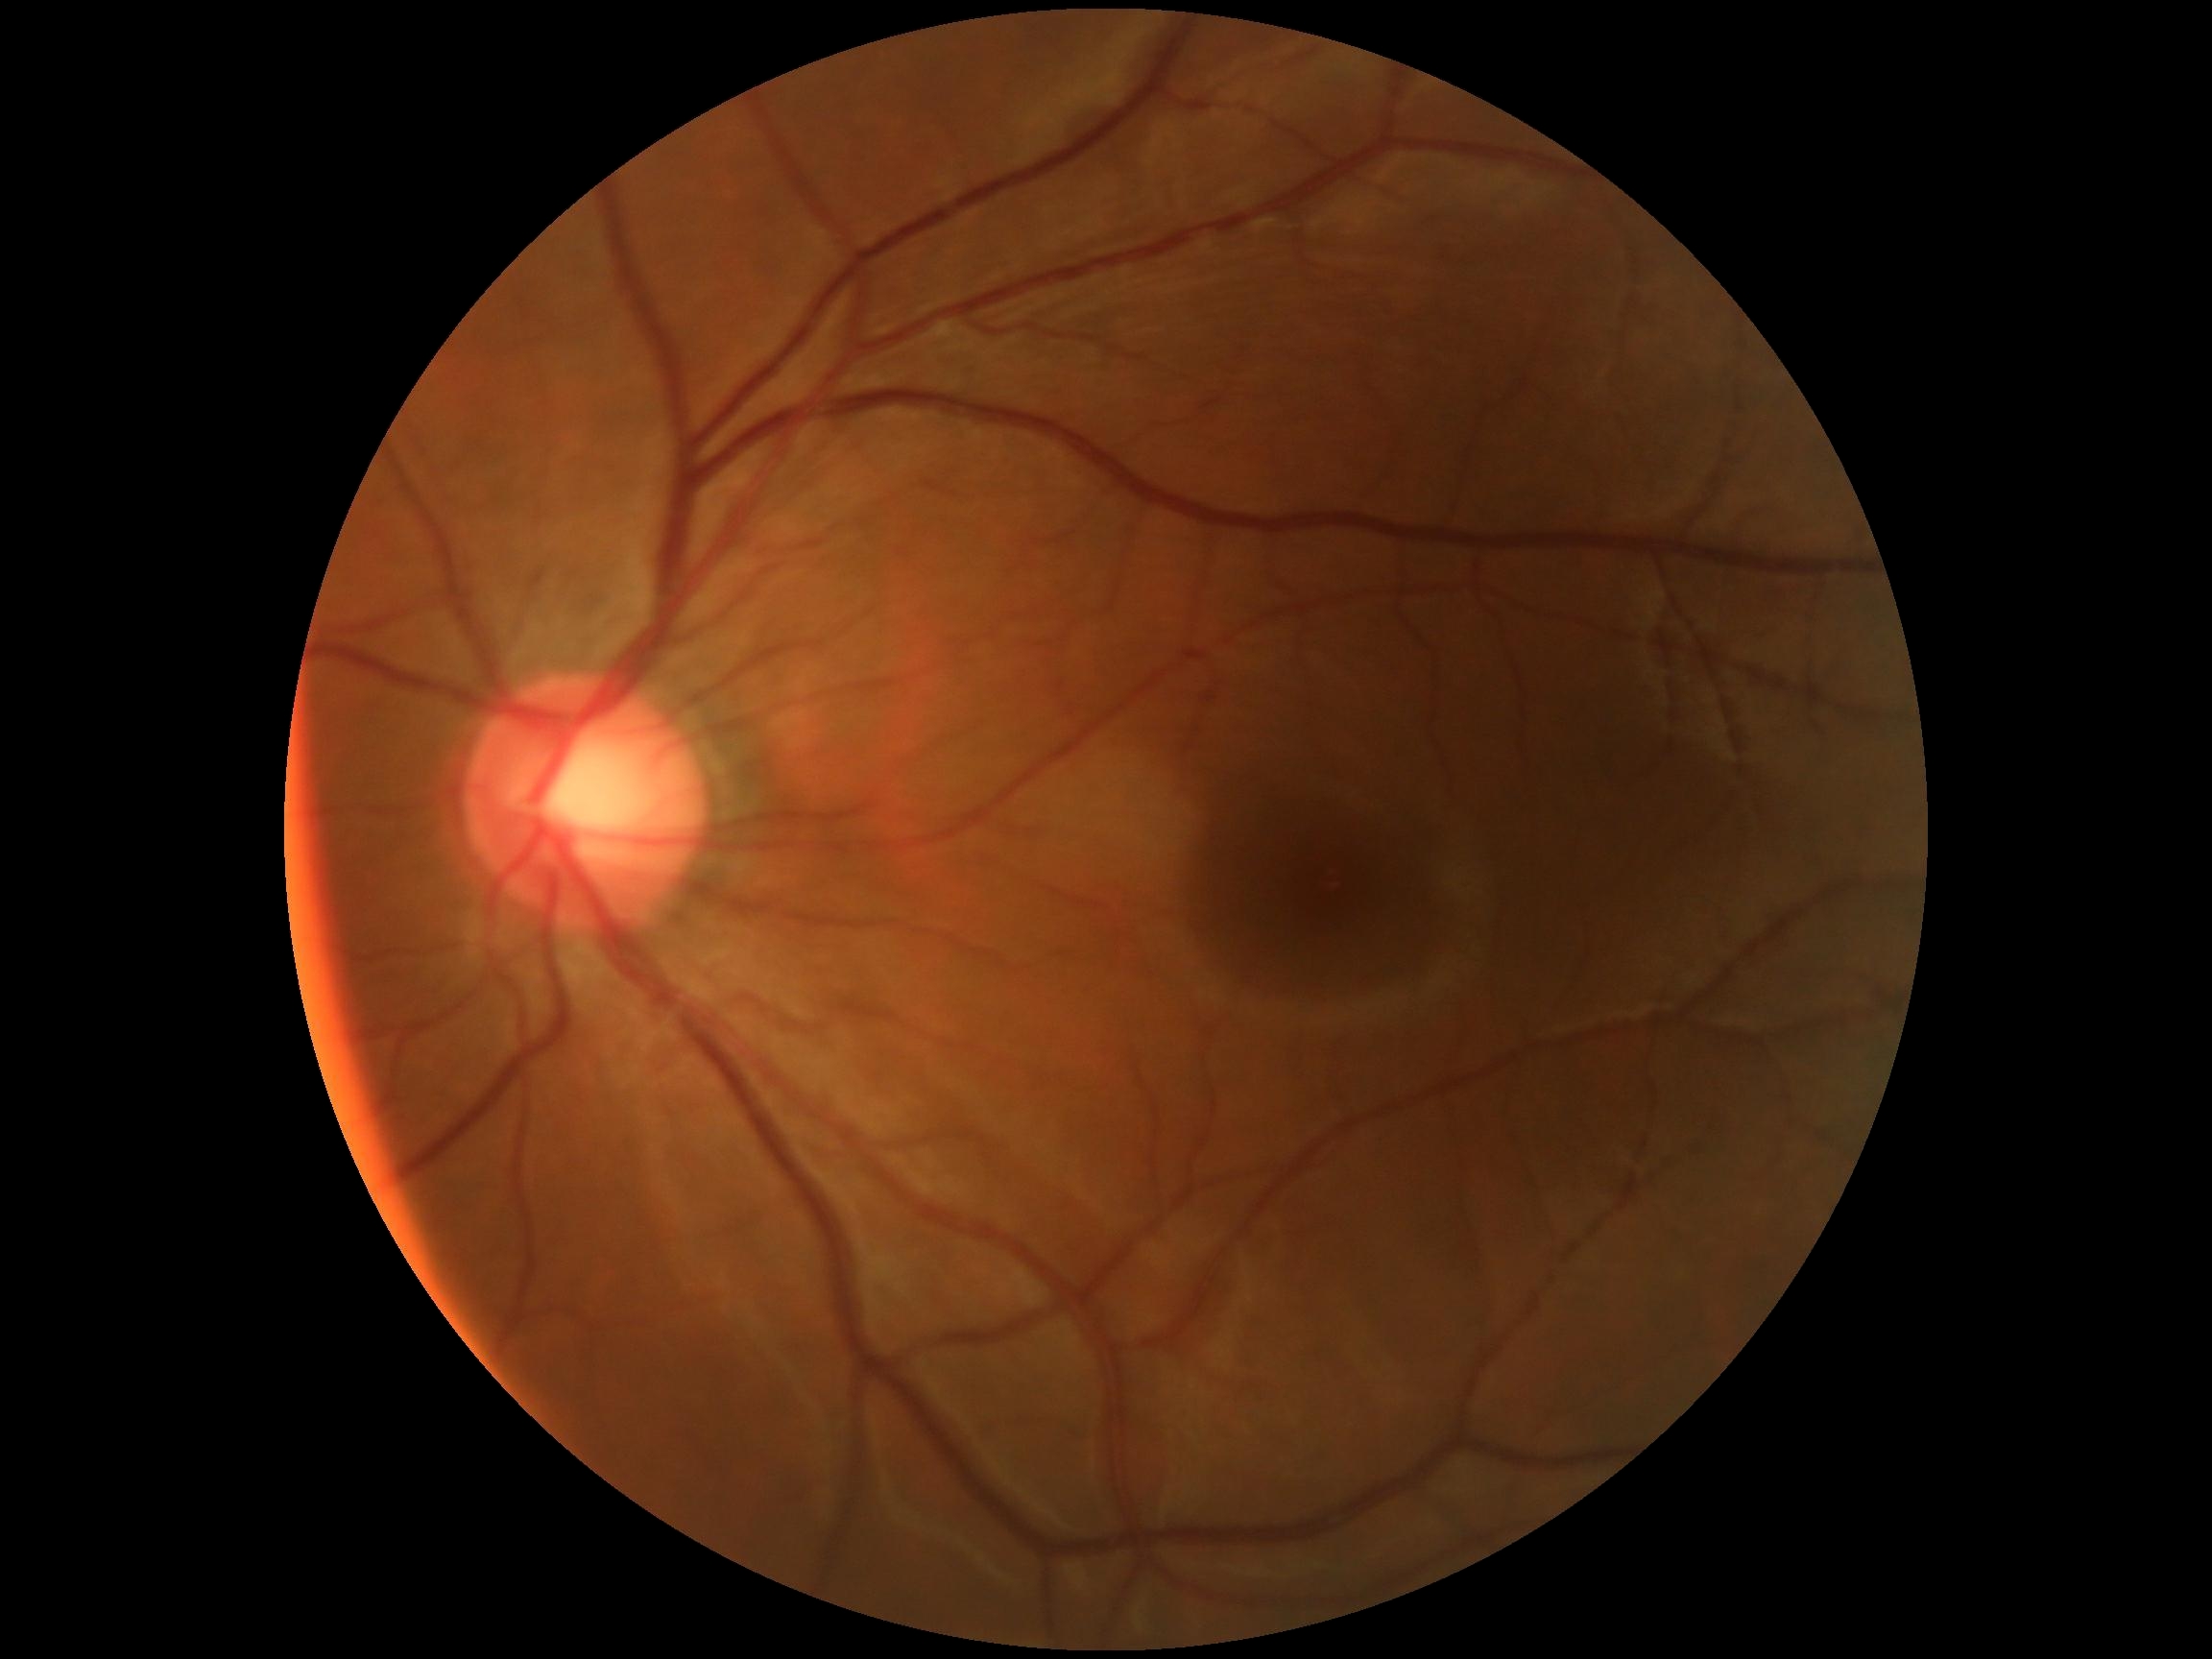

DR is no apparent retinopathy (grade 0). No diabetic retinal disease findings.